Color fundus photograph; 2352x1568; 45° FOV
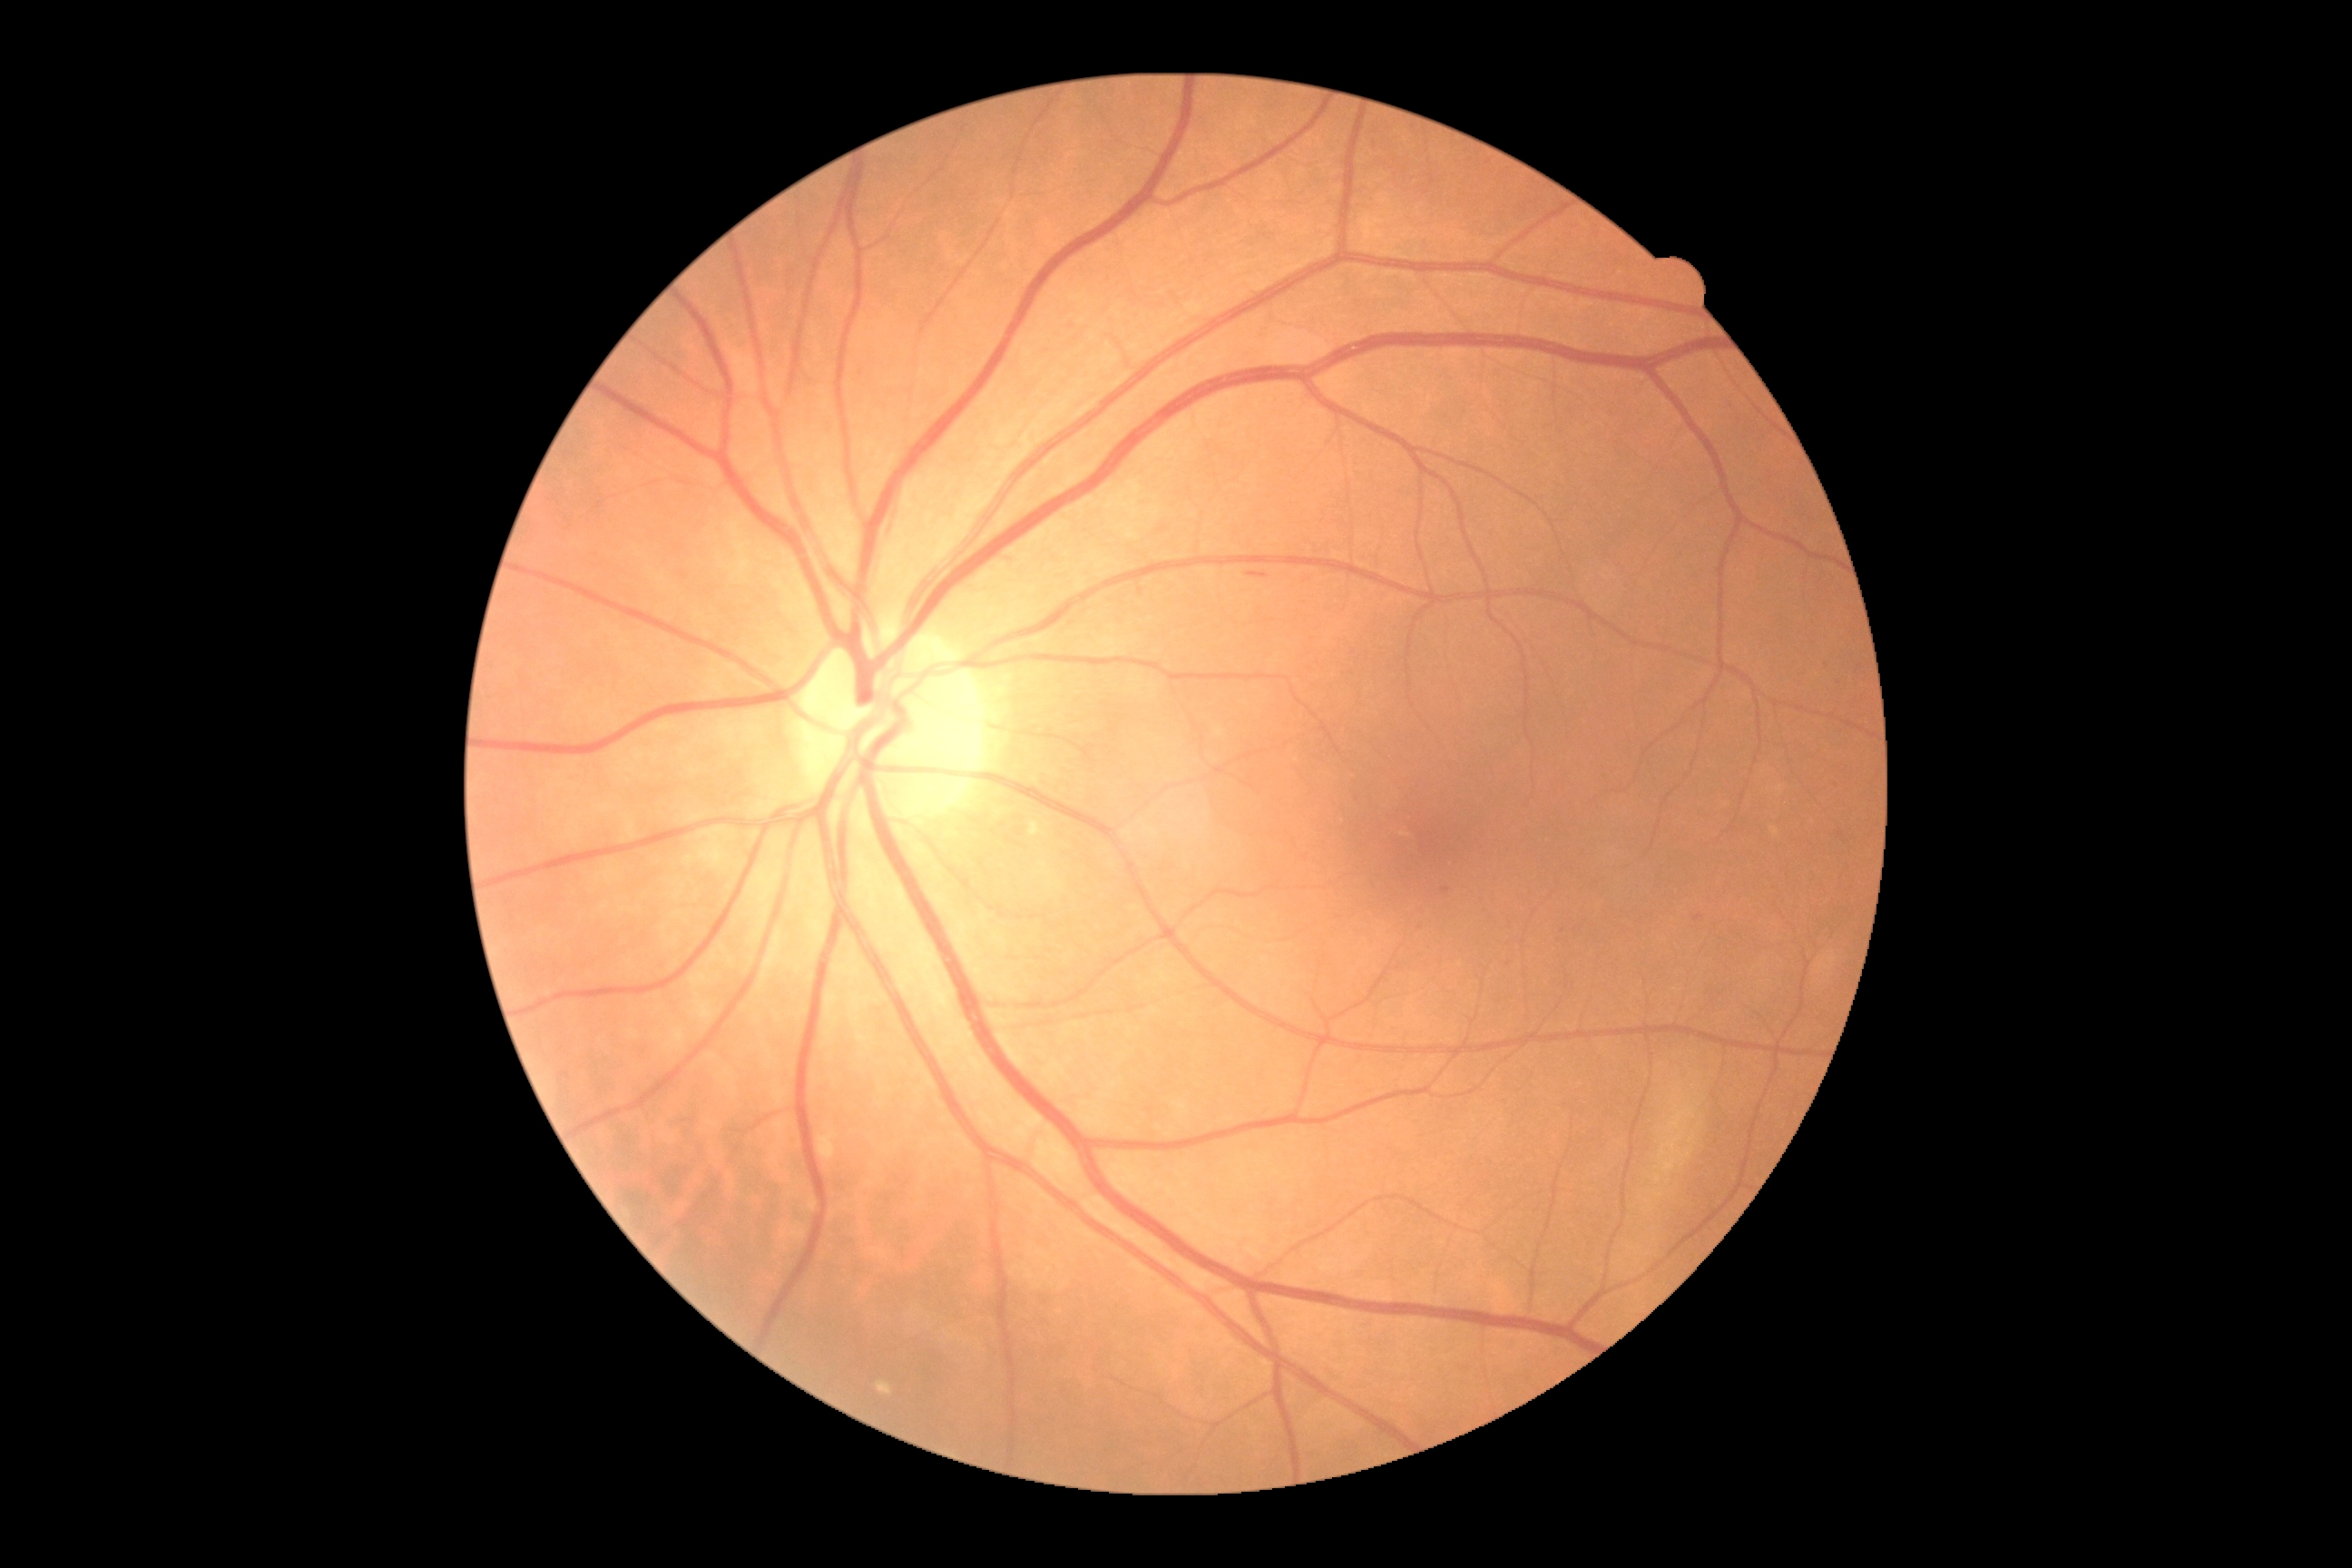

Findings:
– DR class — non-proliferative diabetic retinopathy
– diabetic retinopathy severity — moderate non-proliferative diabetic retinopathy (grade 2)